Modified Davis classification. Without pupil dilation — 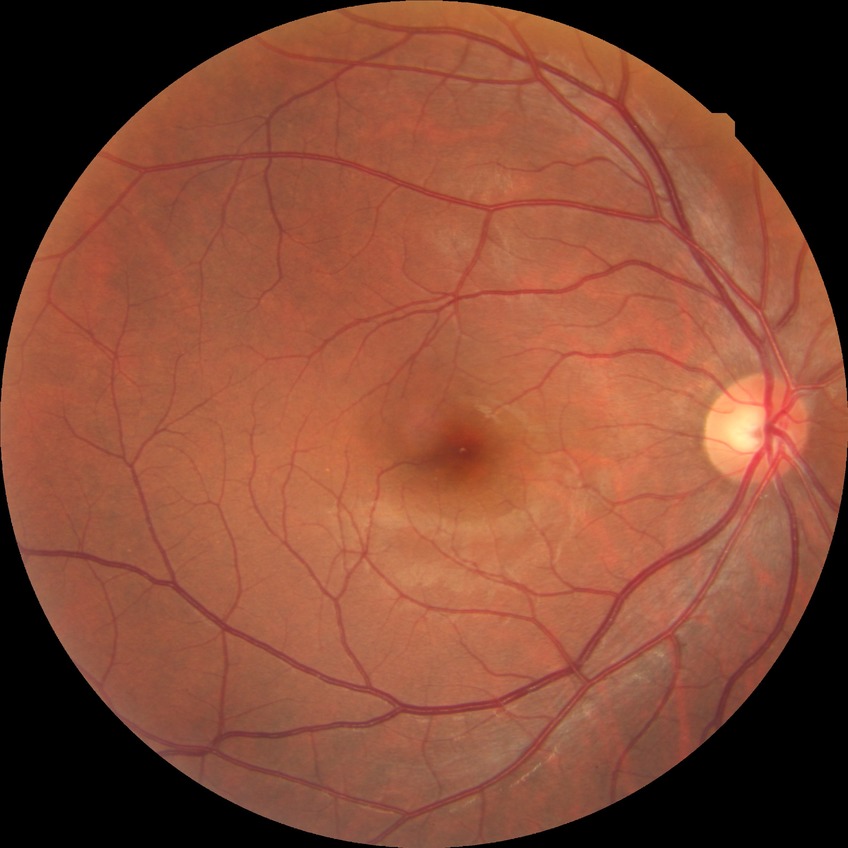 diabetic retinopathy (DR): no diabetic retinopathy (NDR).